CFP — 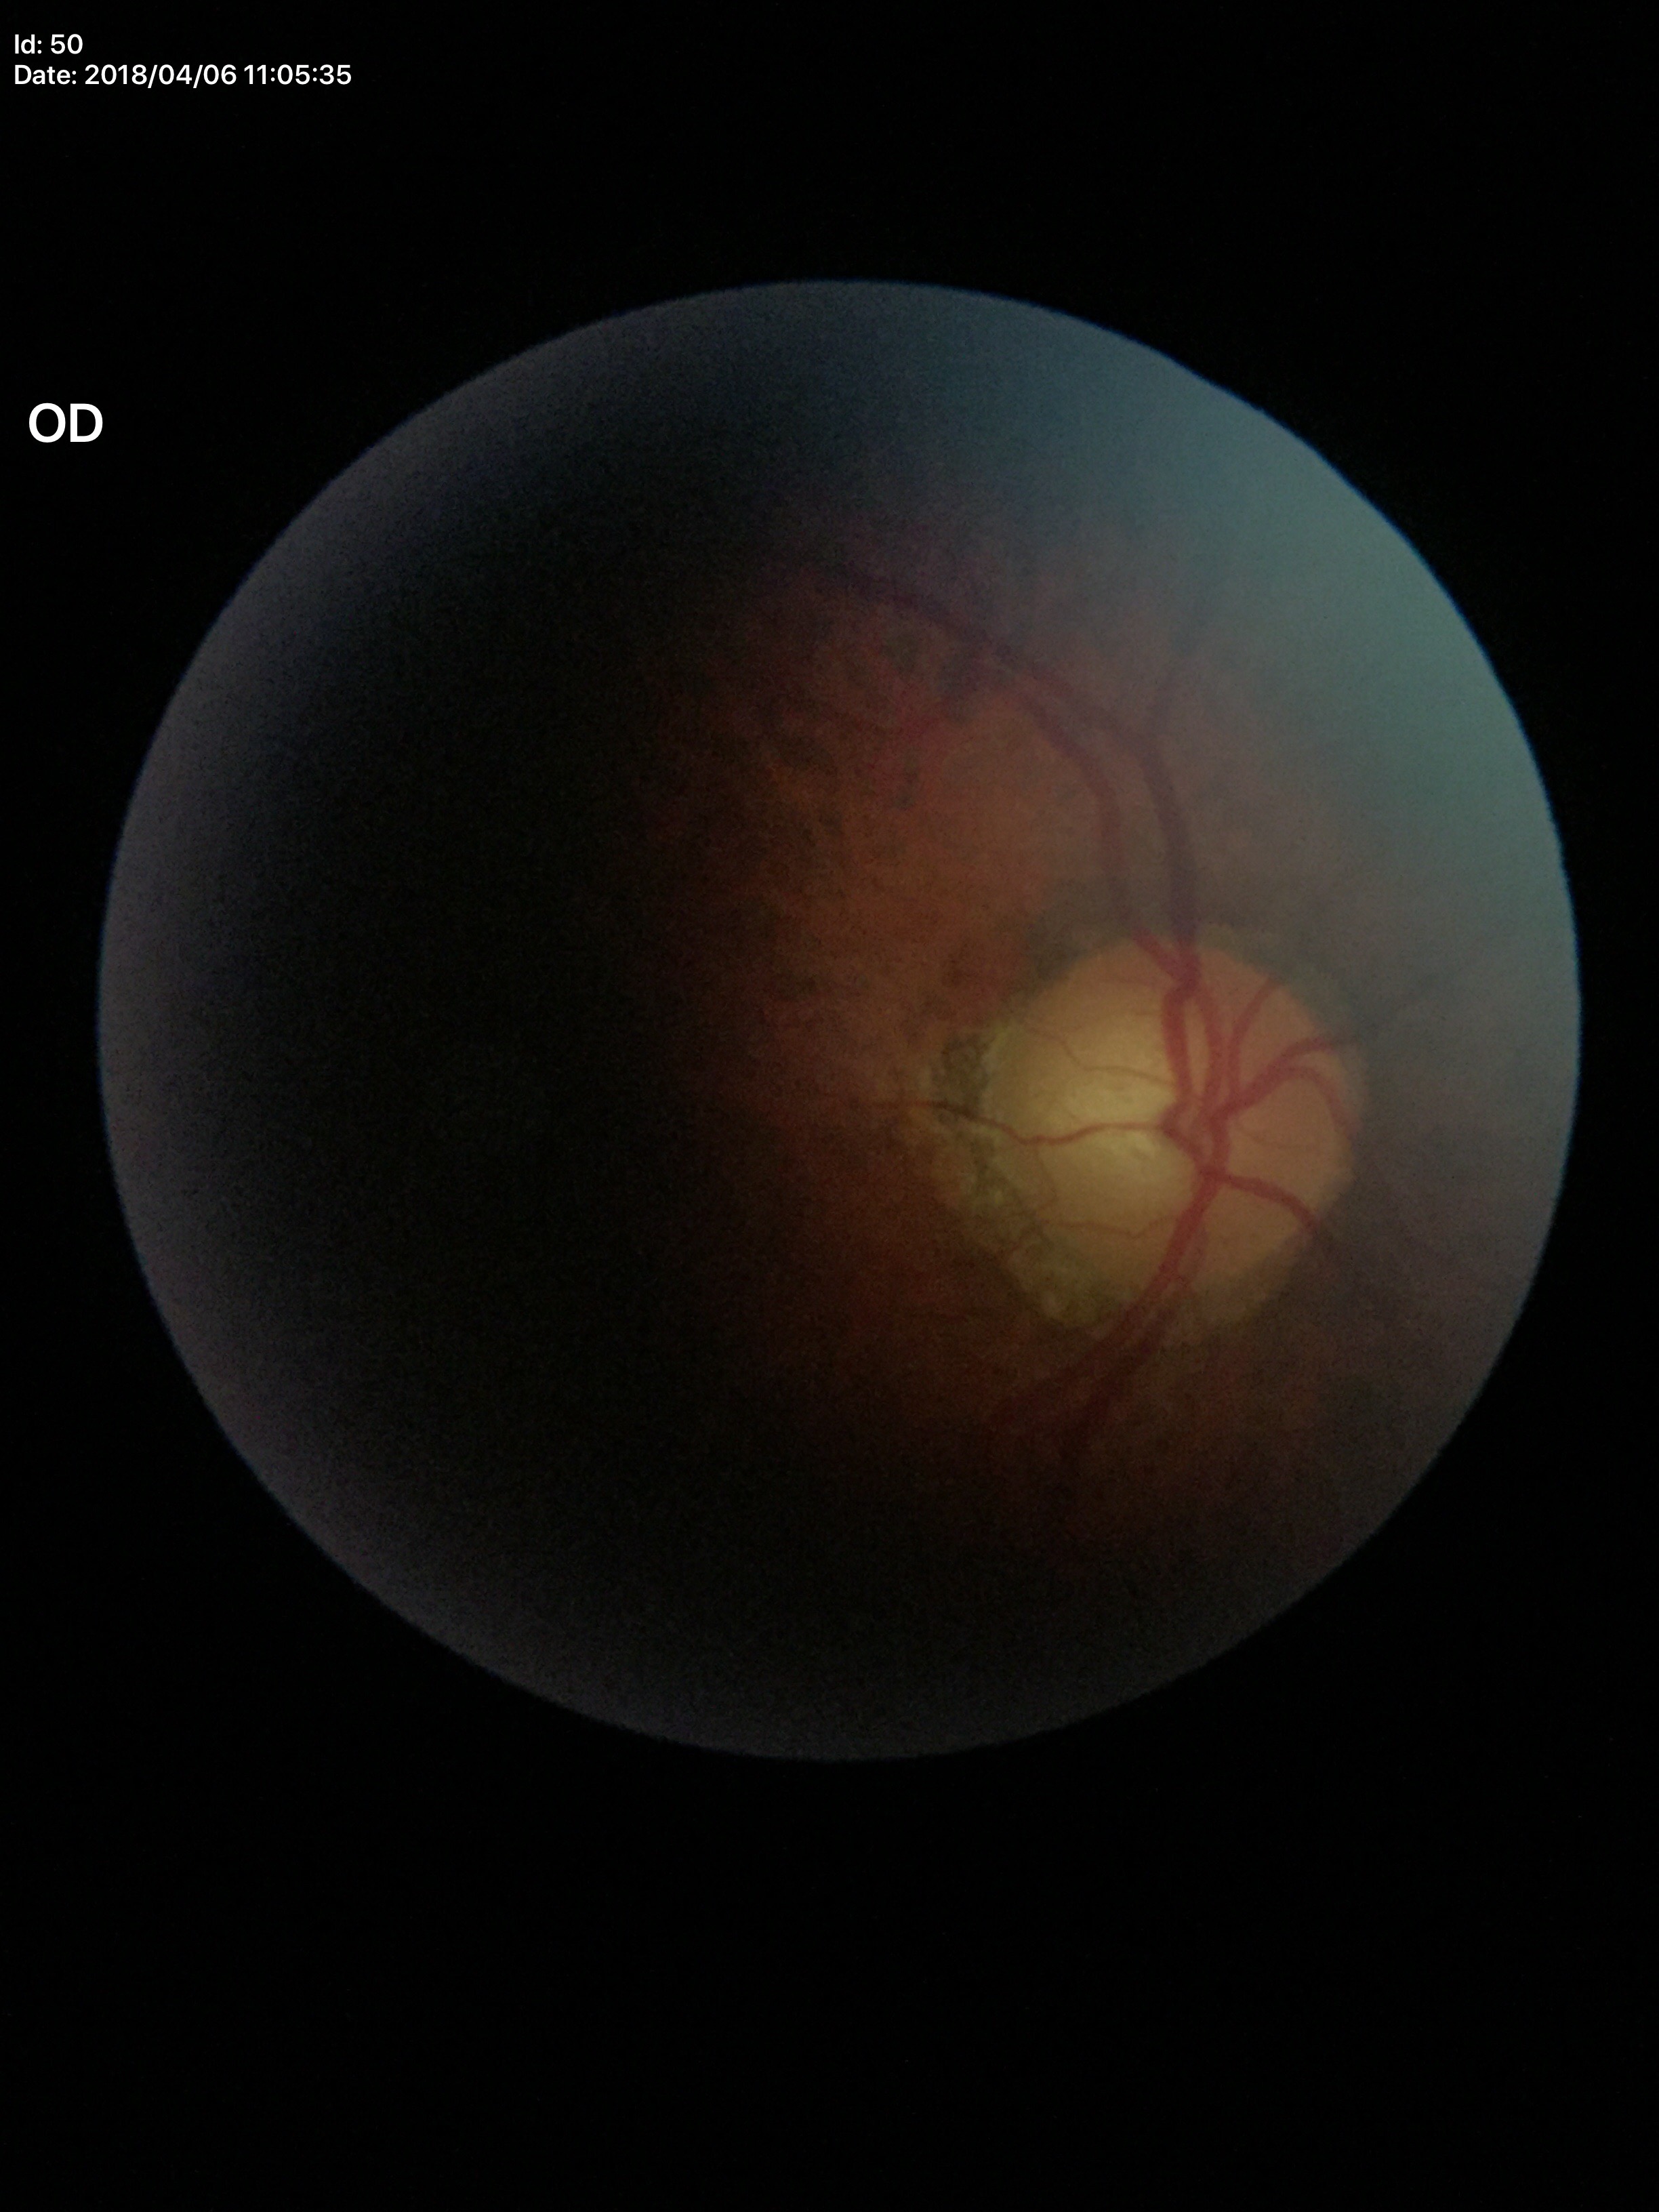 Vertical C/D ratio (VCDR): 0.64. Glaucoma decision: suspicious (4 of 5 graders flagged glaucoma suspect).